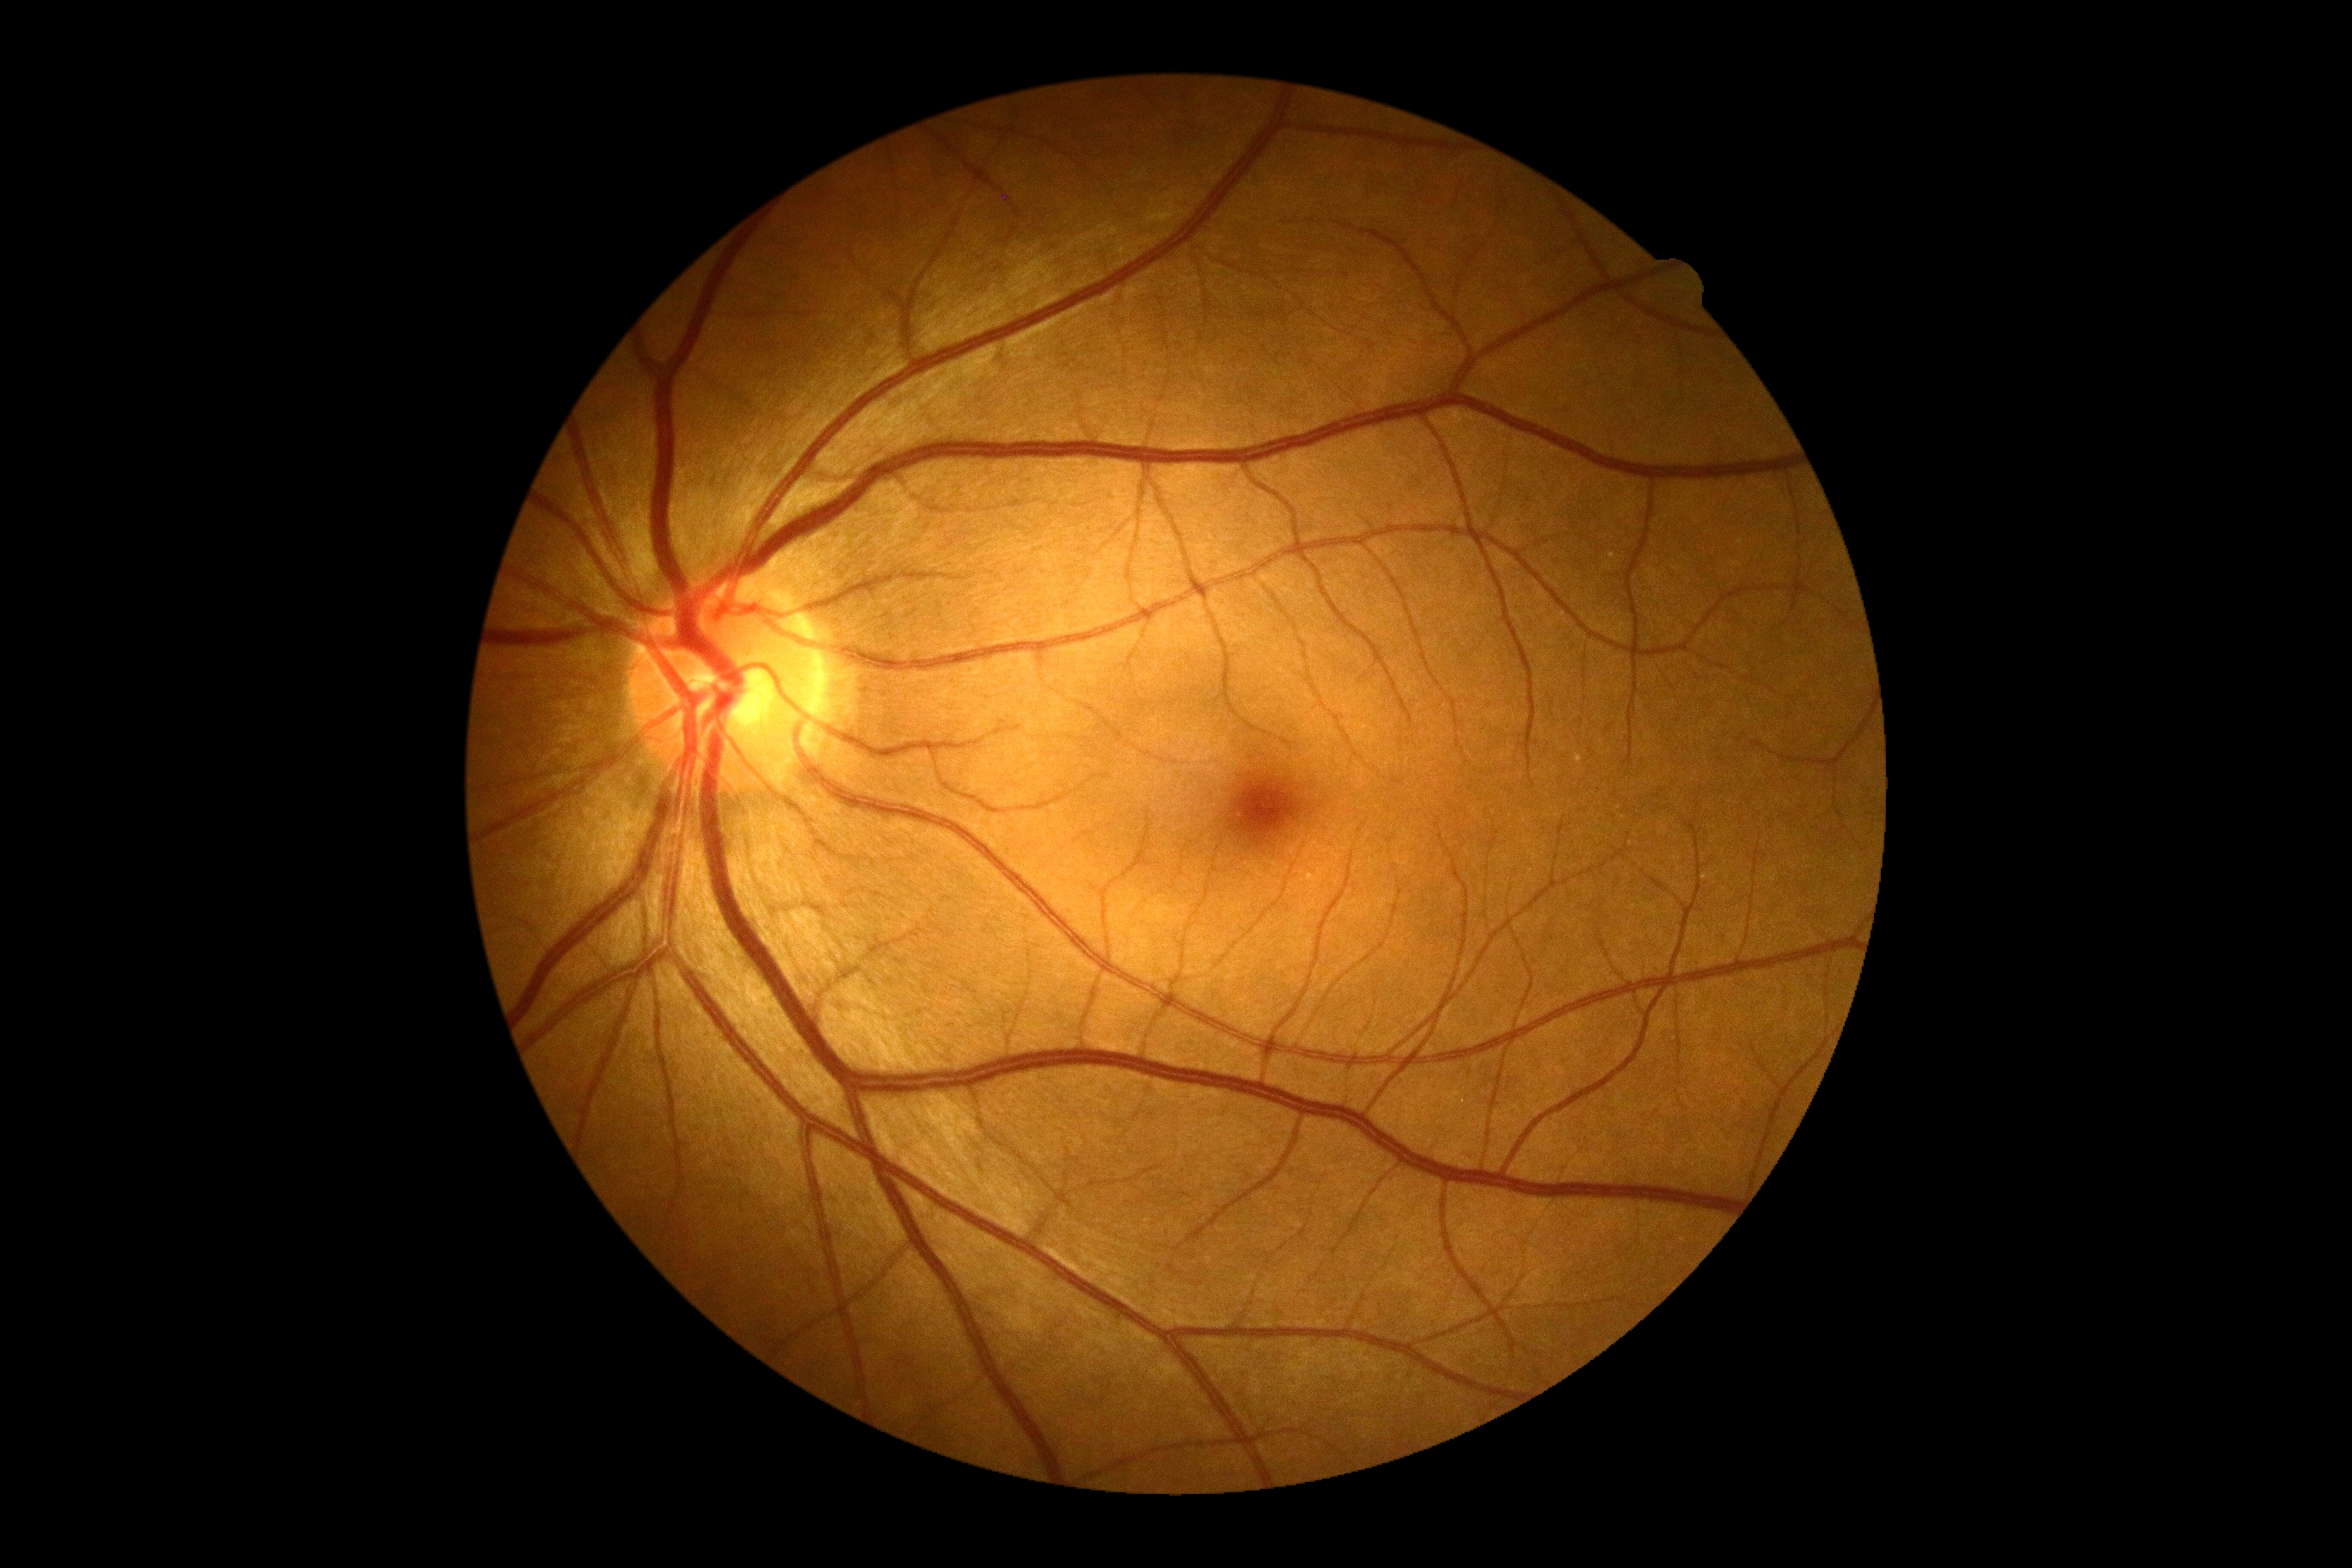
DR grade@no apparent diabetic retinopathy (0).